45° FOV:
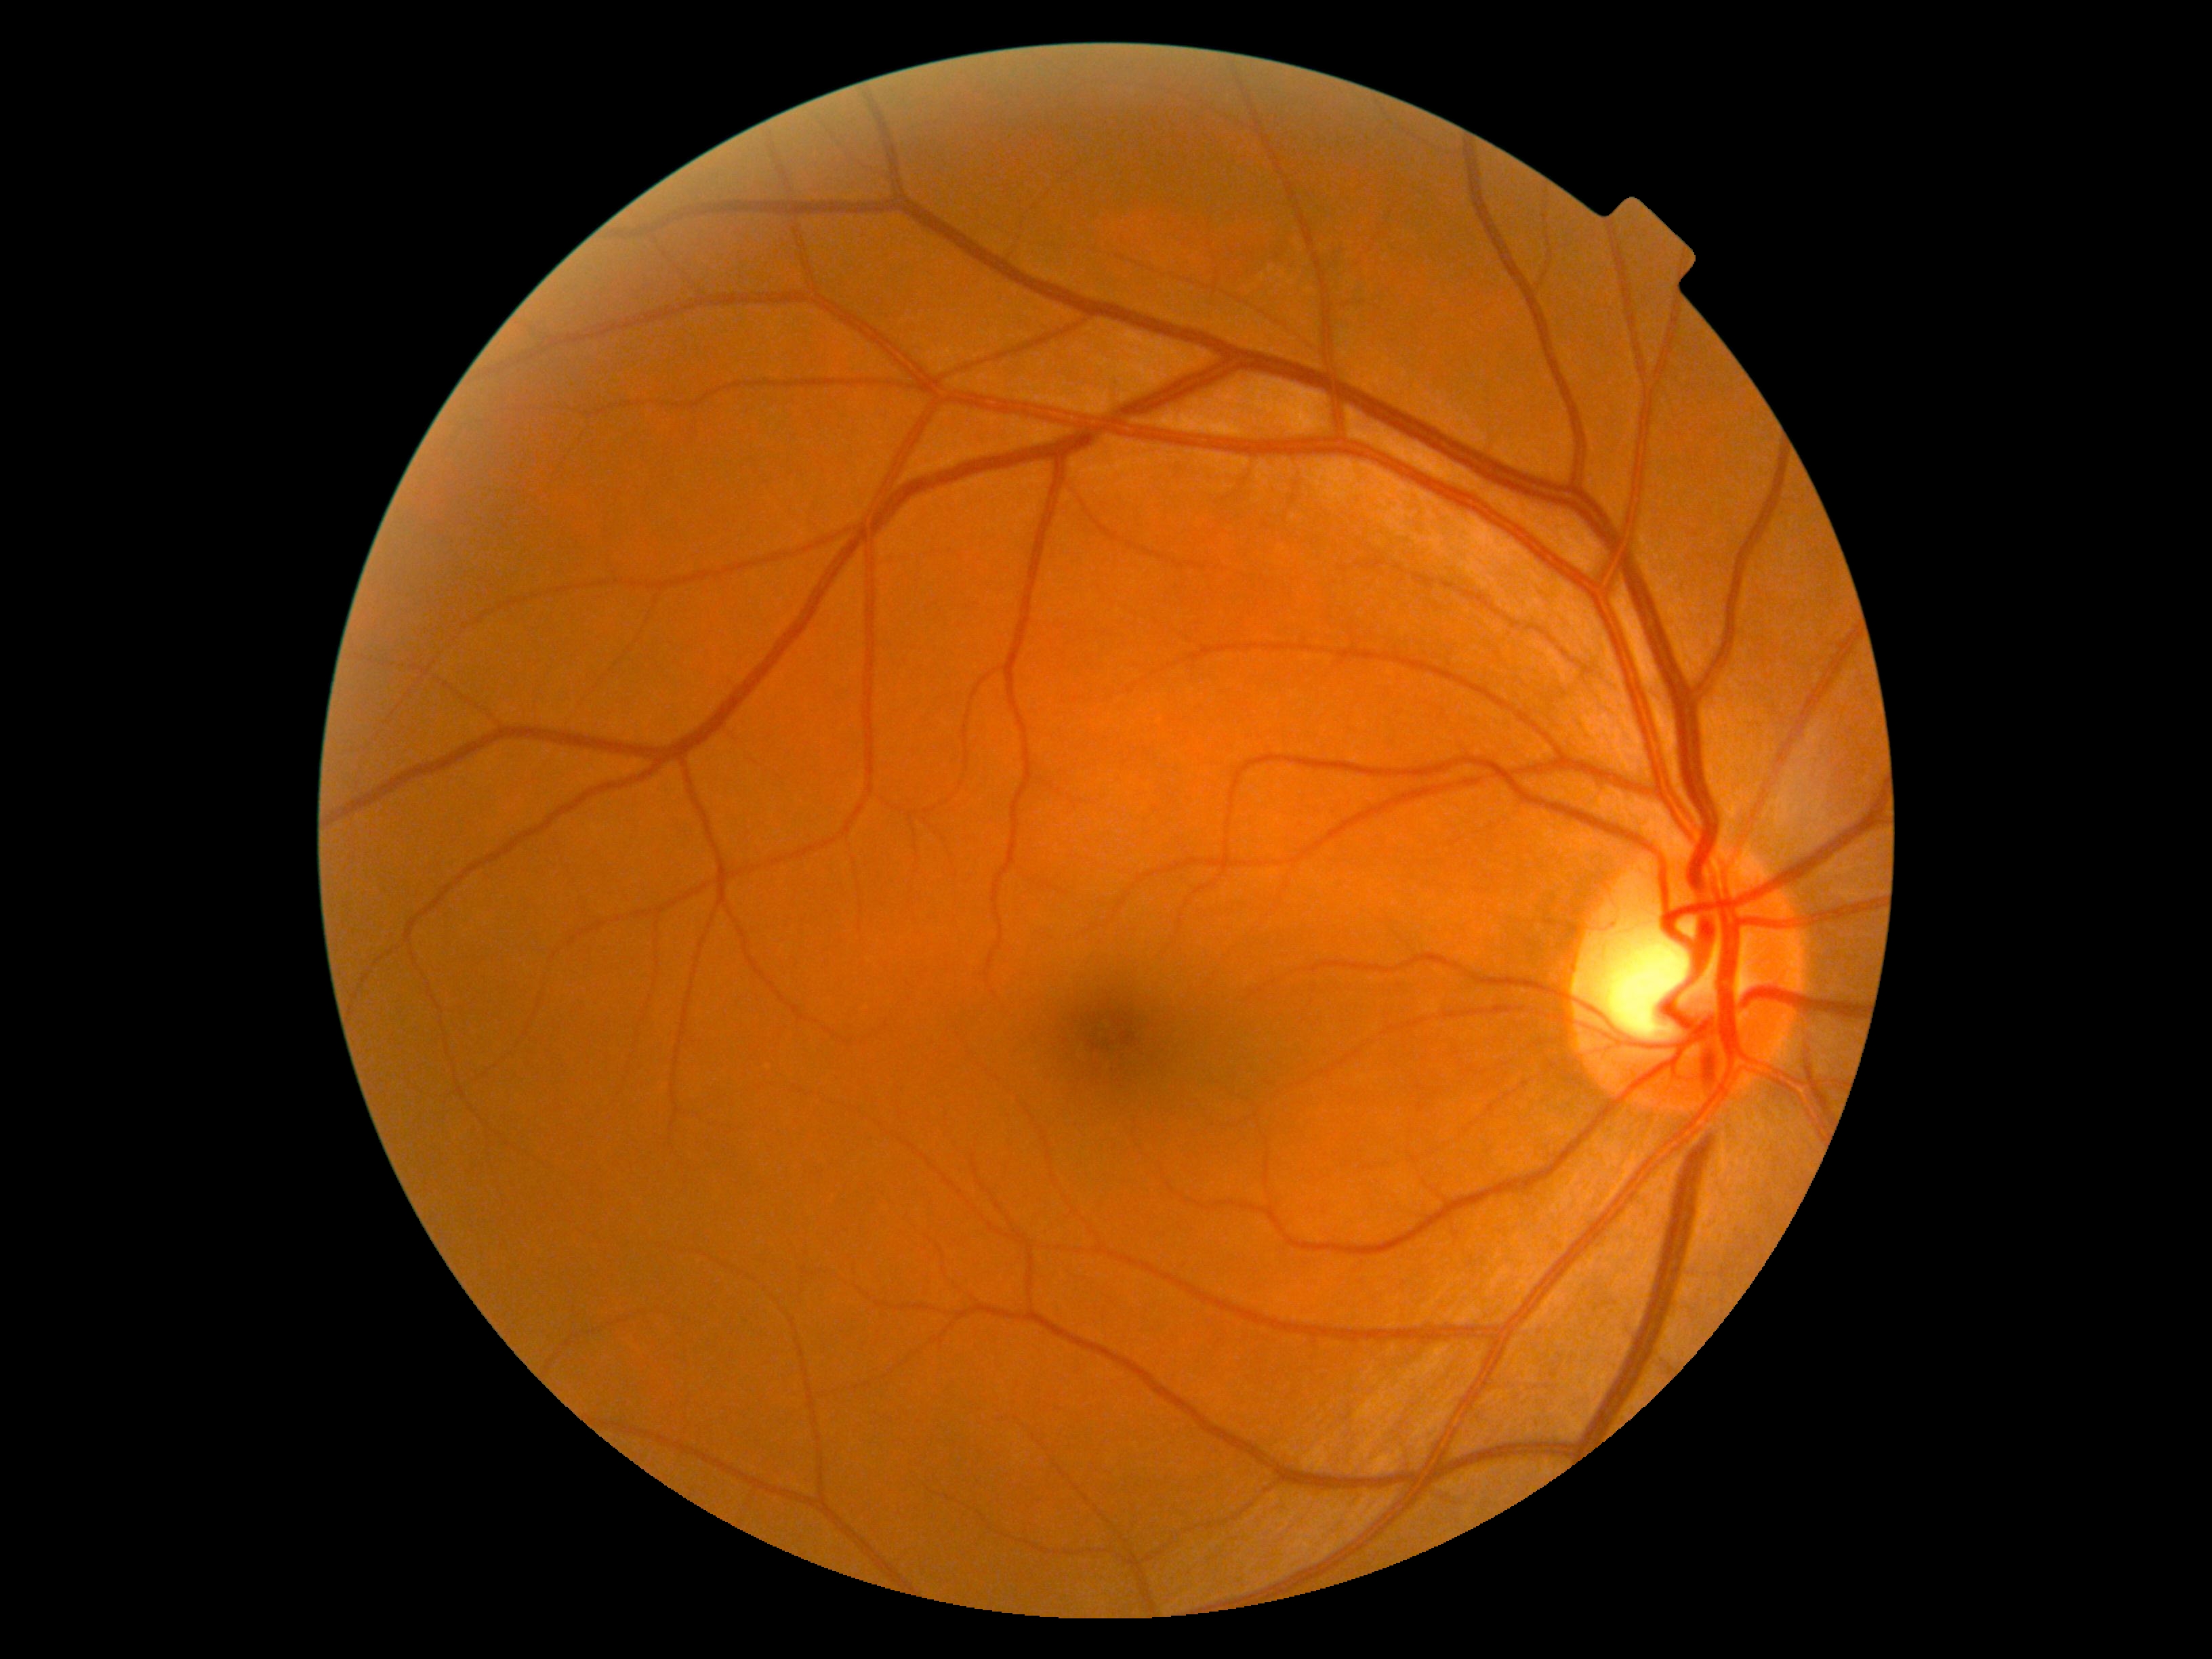 Diabetic retinopathy grade: 0.